CFP:
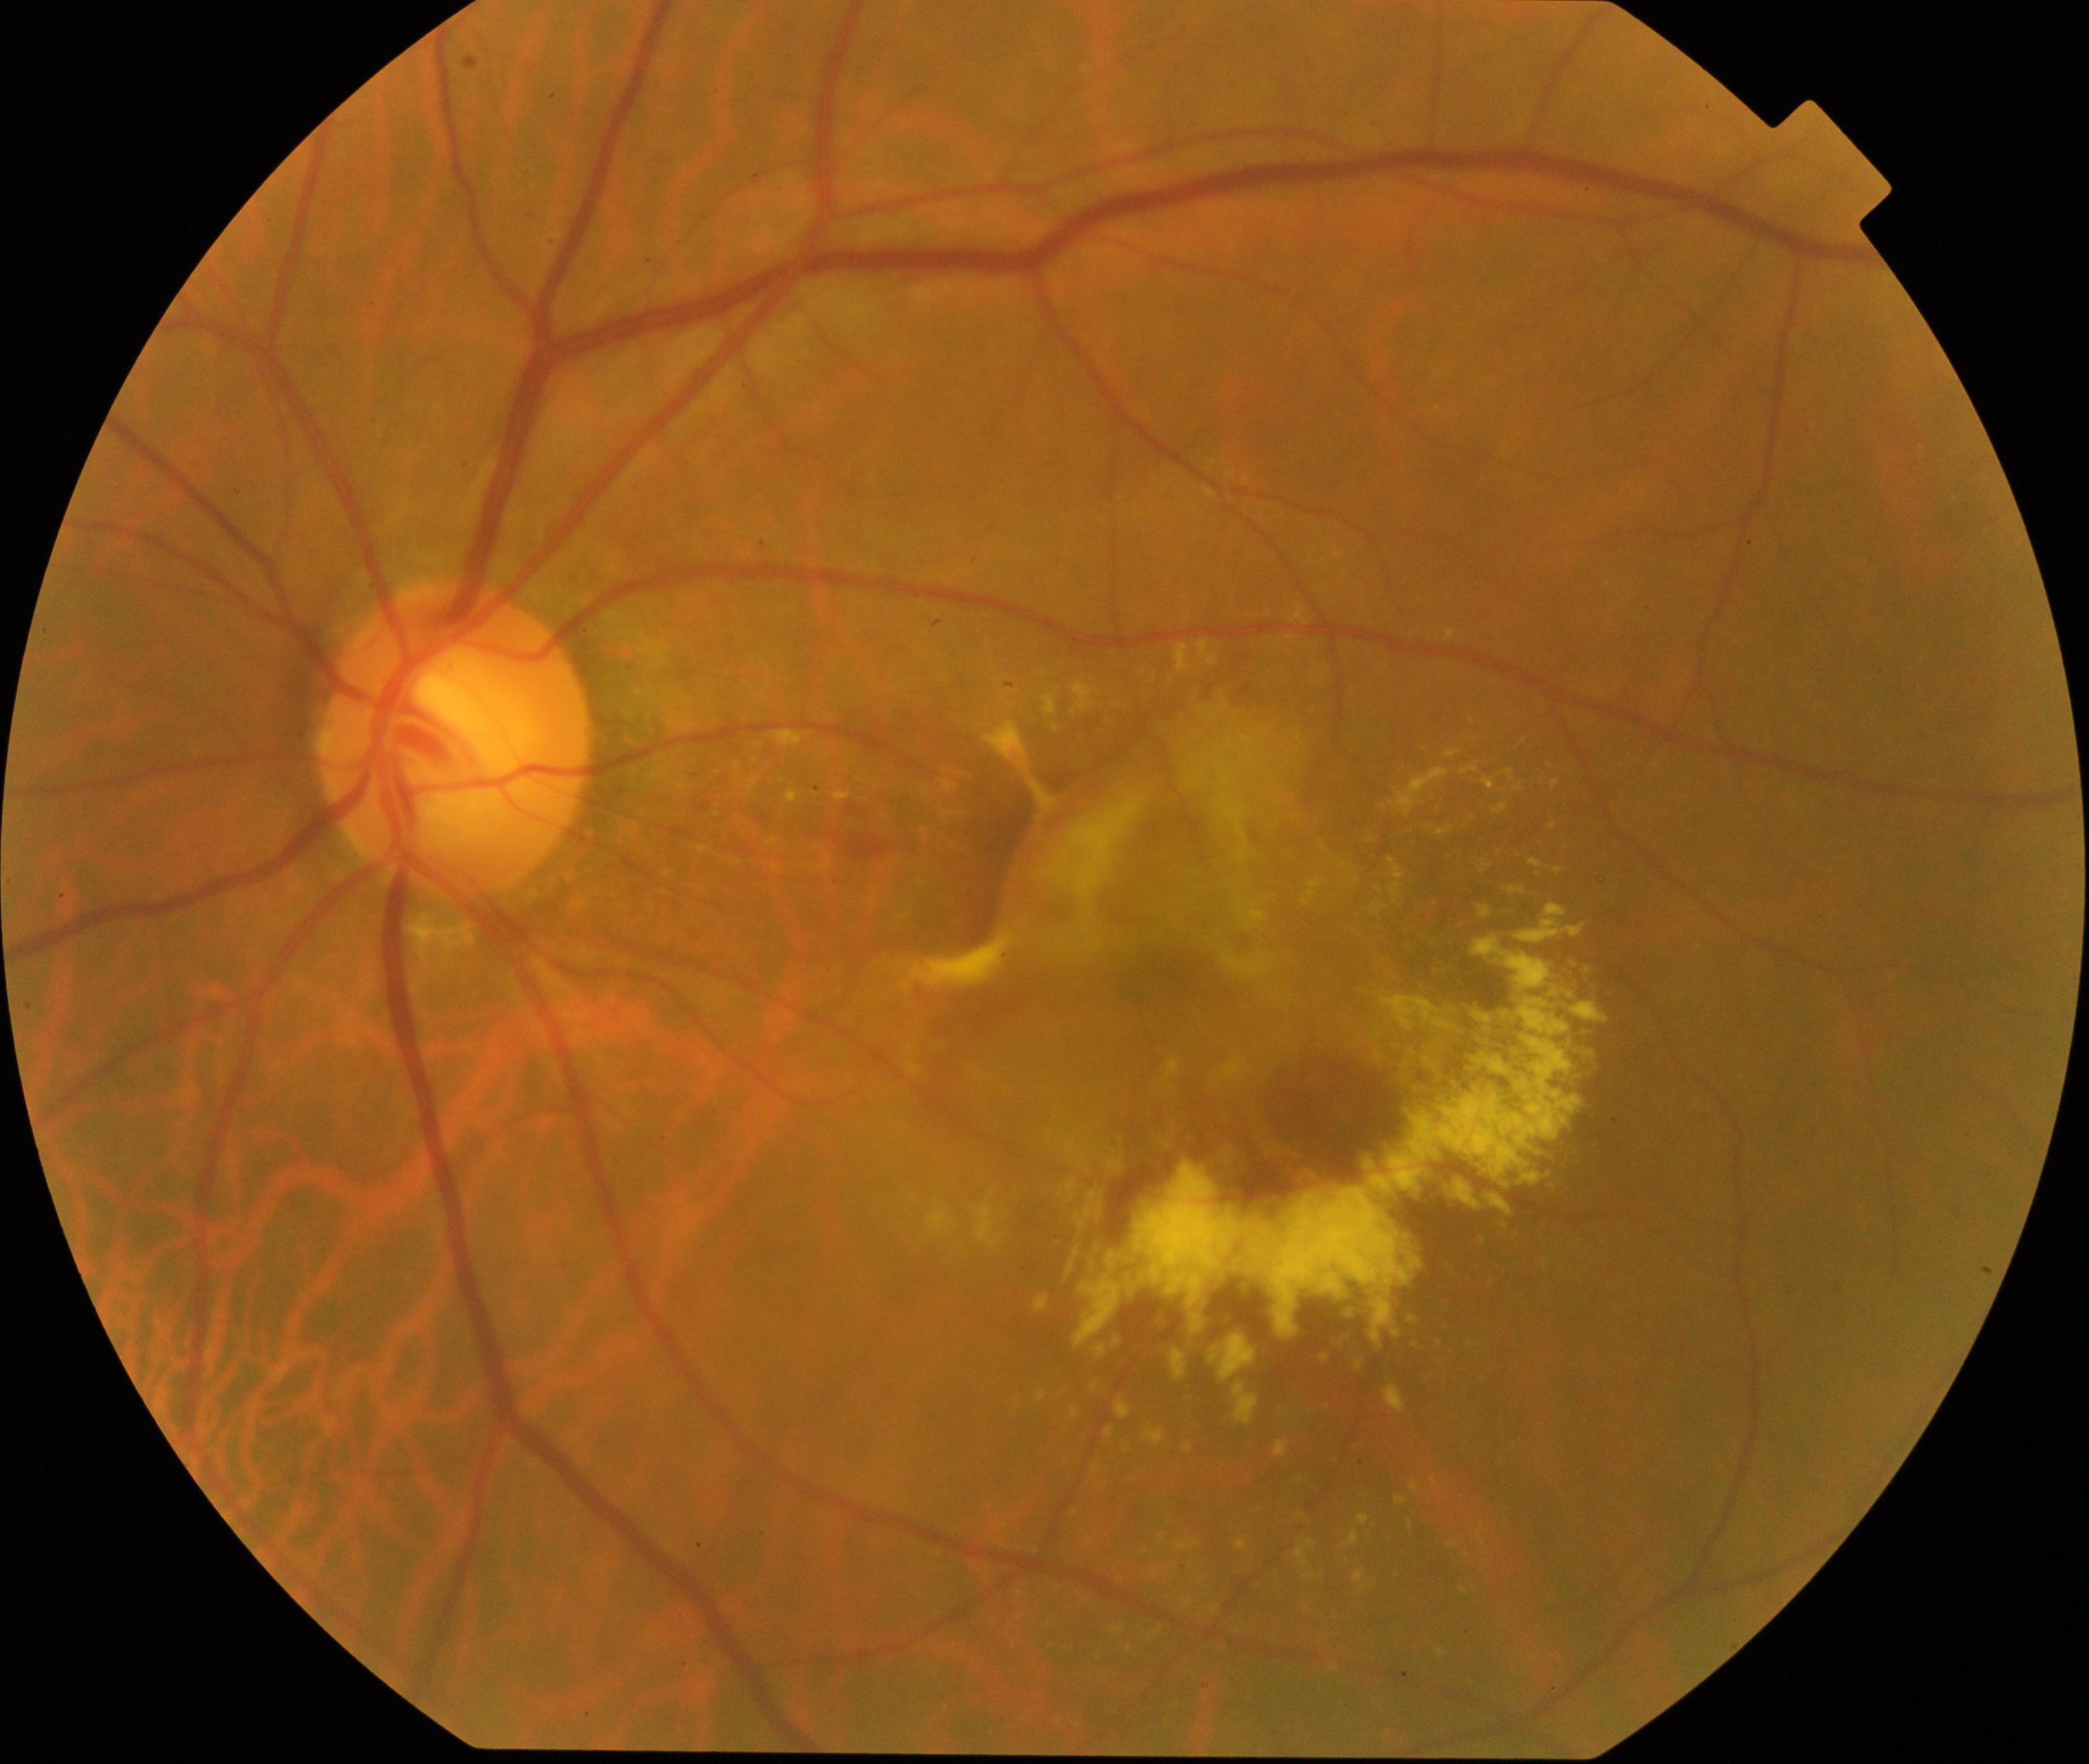
Findings: maculopathy.